Acquired with a Nidek AFC-330.
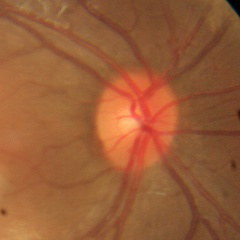 Demonstrates no glaucomatous optic neuropathy.